640 by 480 pixels. Pediatric wide-field fundus photograph: 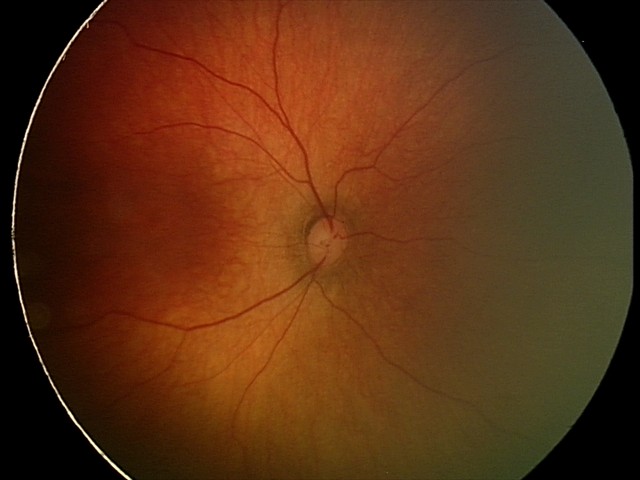 Q: What is the diagnosis from this examination?
A: physiological finding